45° FOV, retinal fundus photograph: 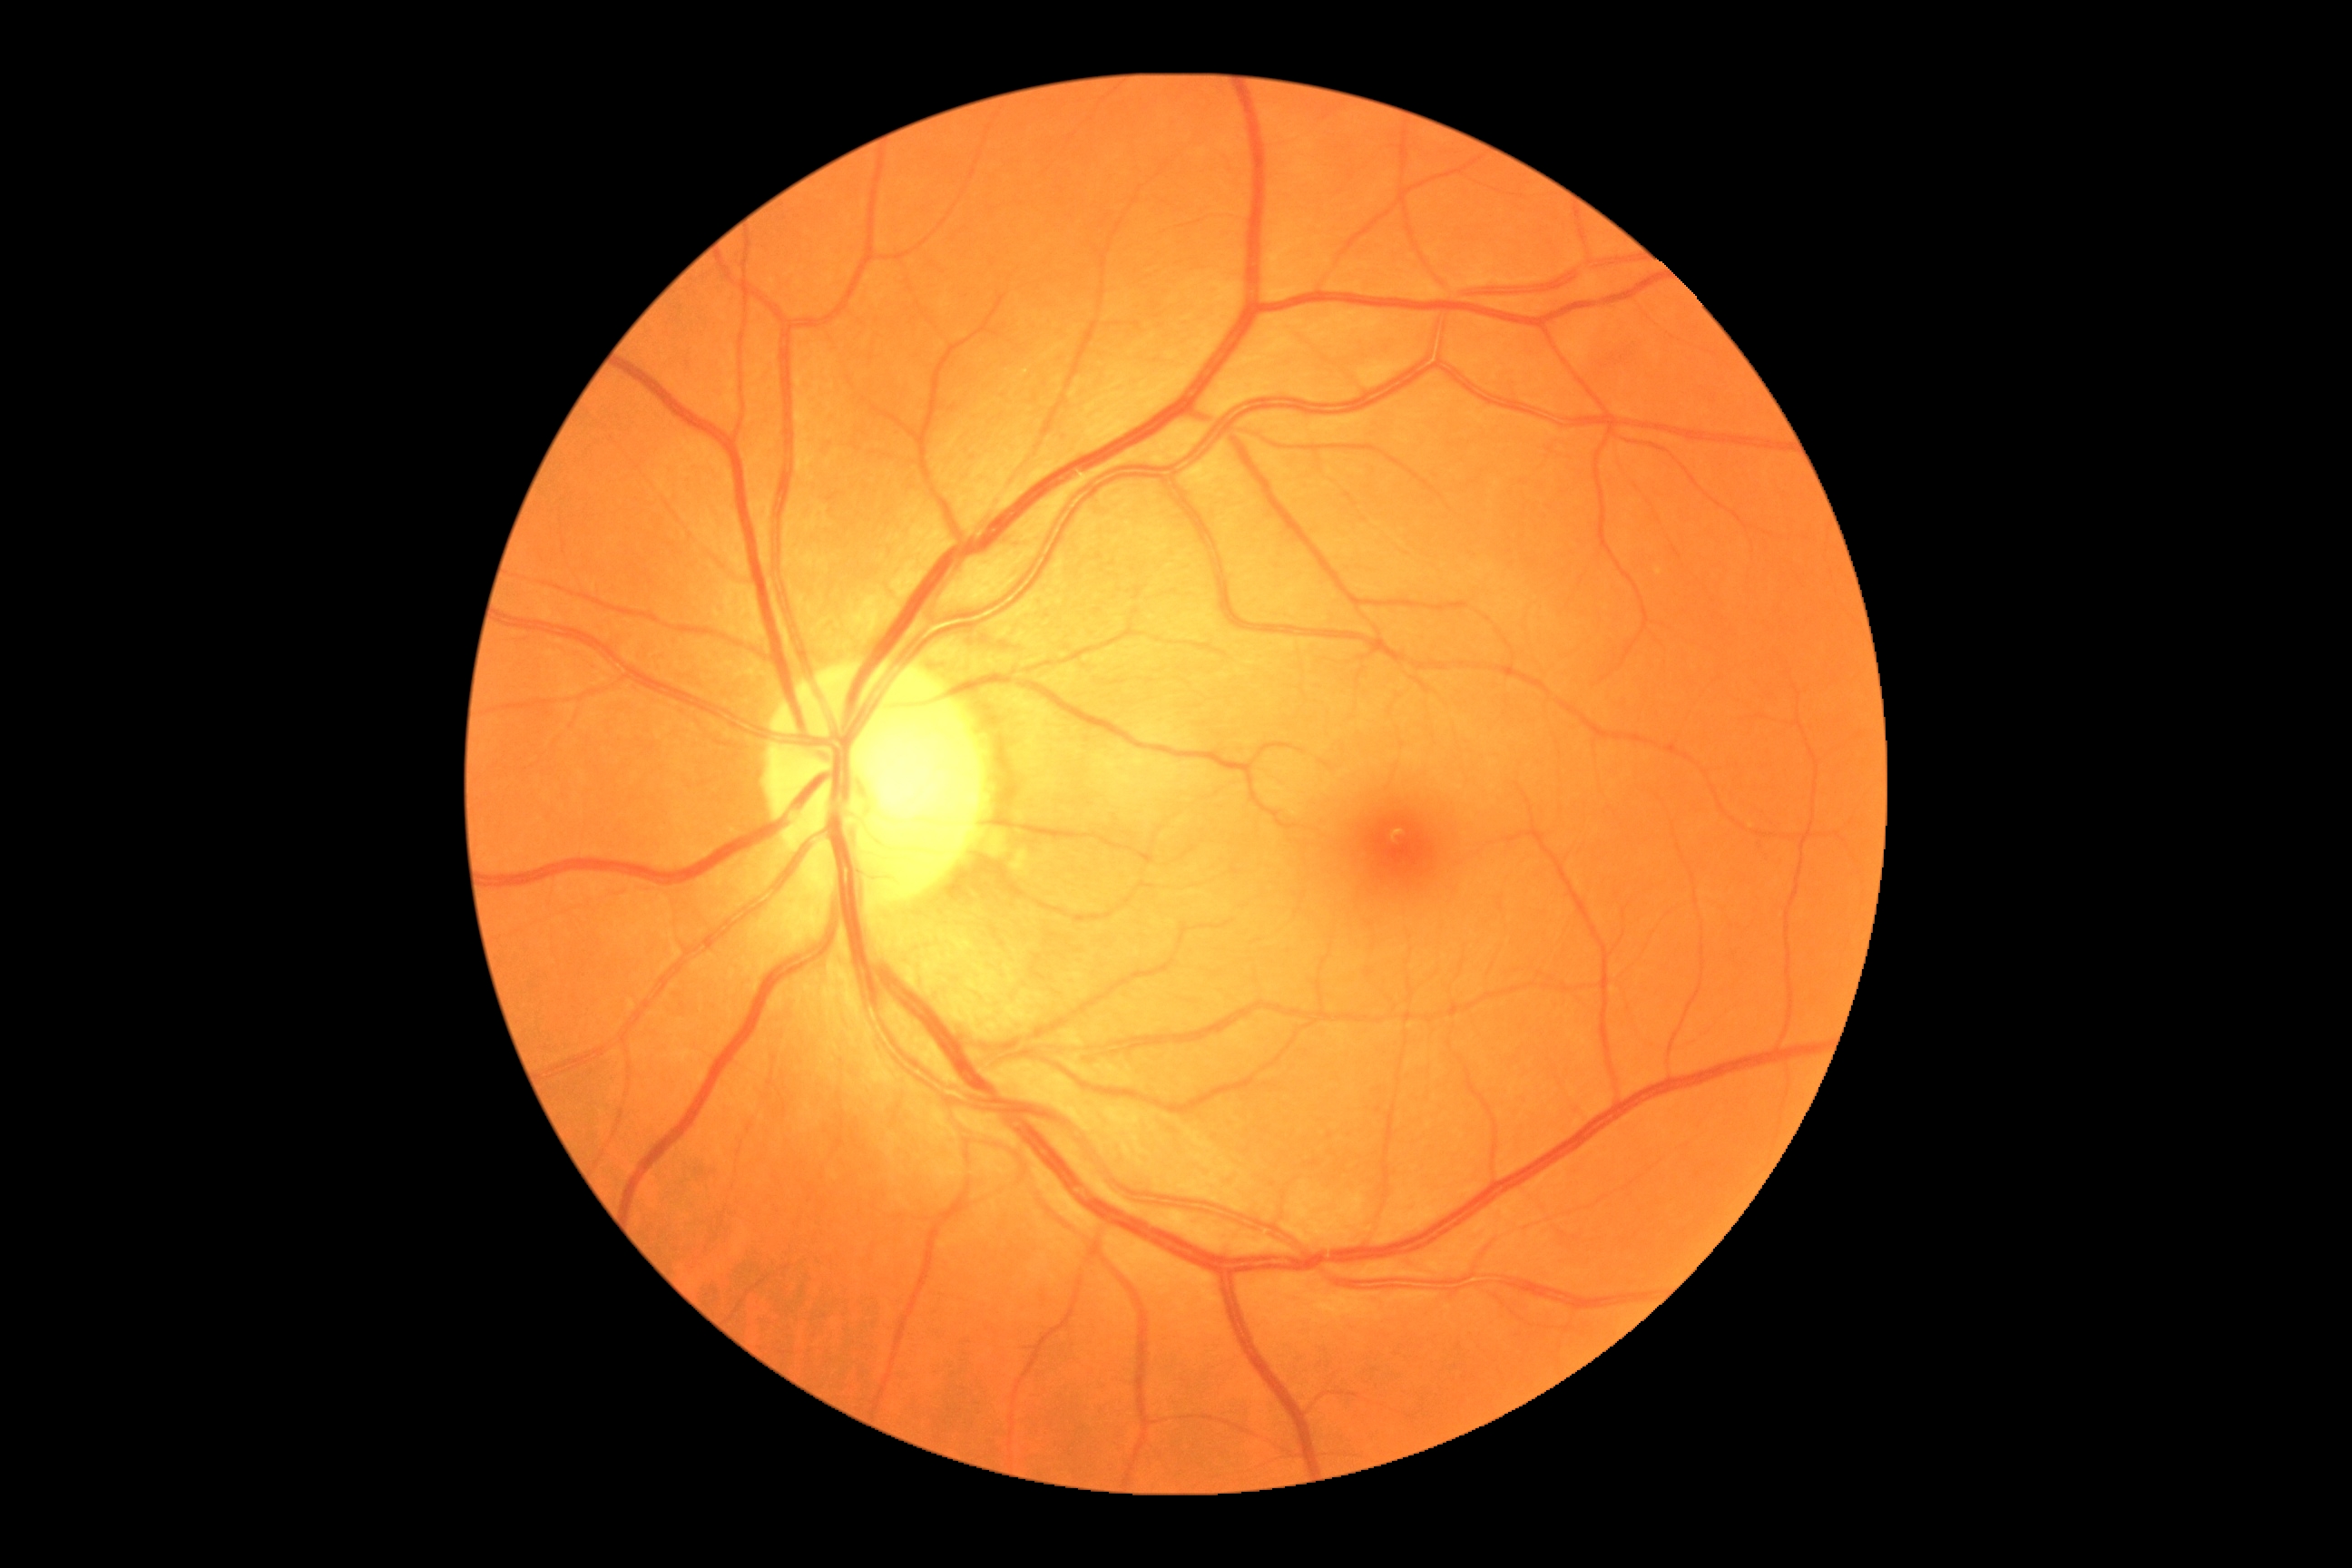

Diabetic retinopathy is no apparent diabetic retinopathy (grade 0).